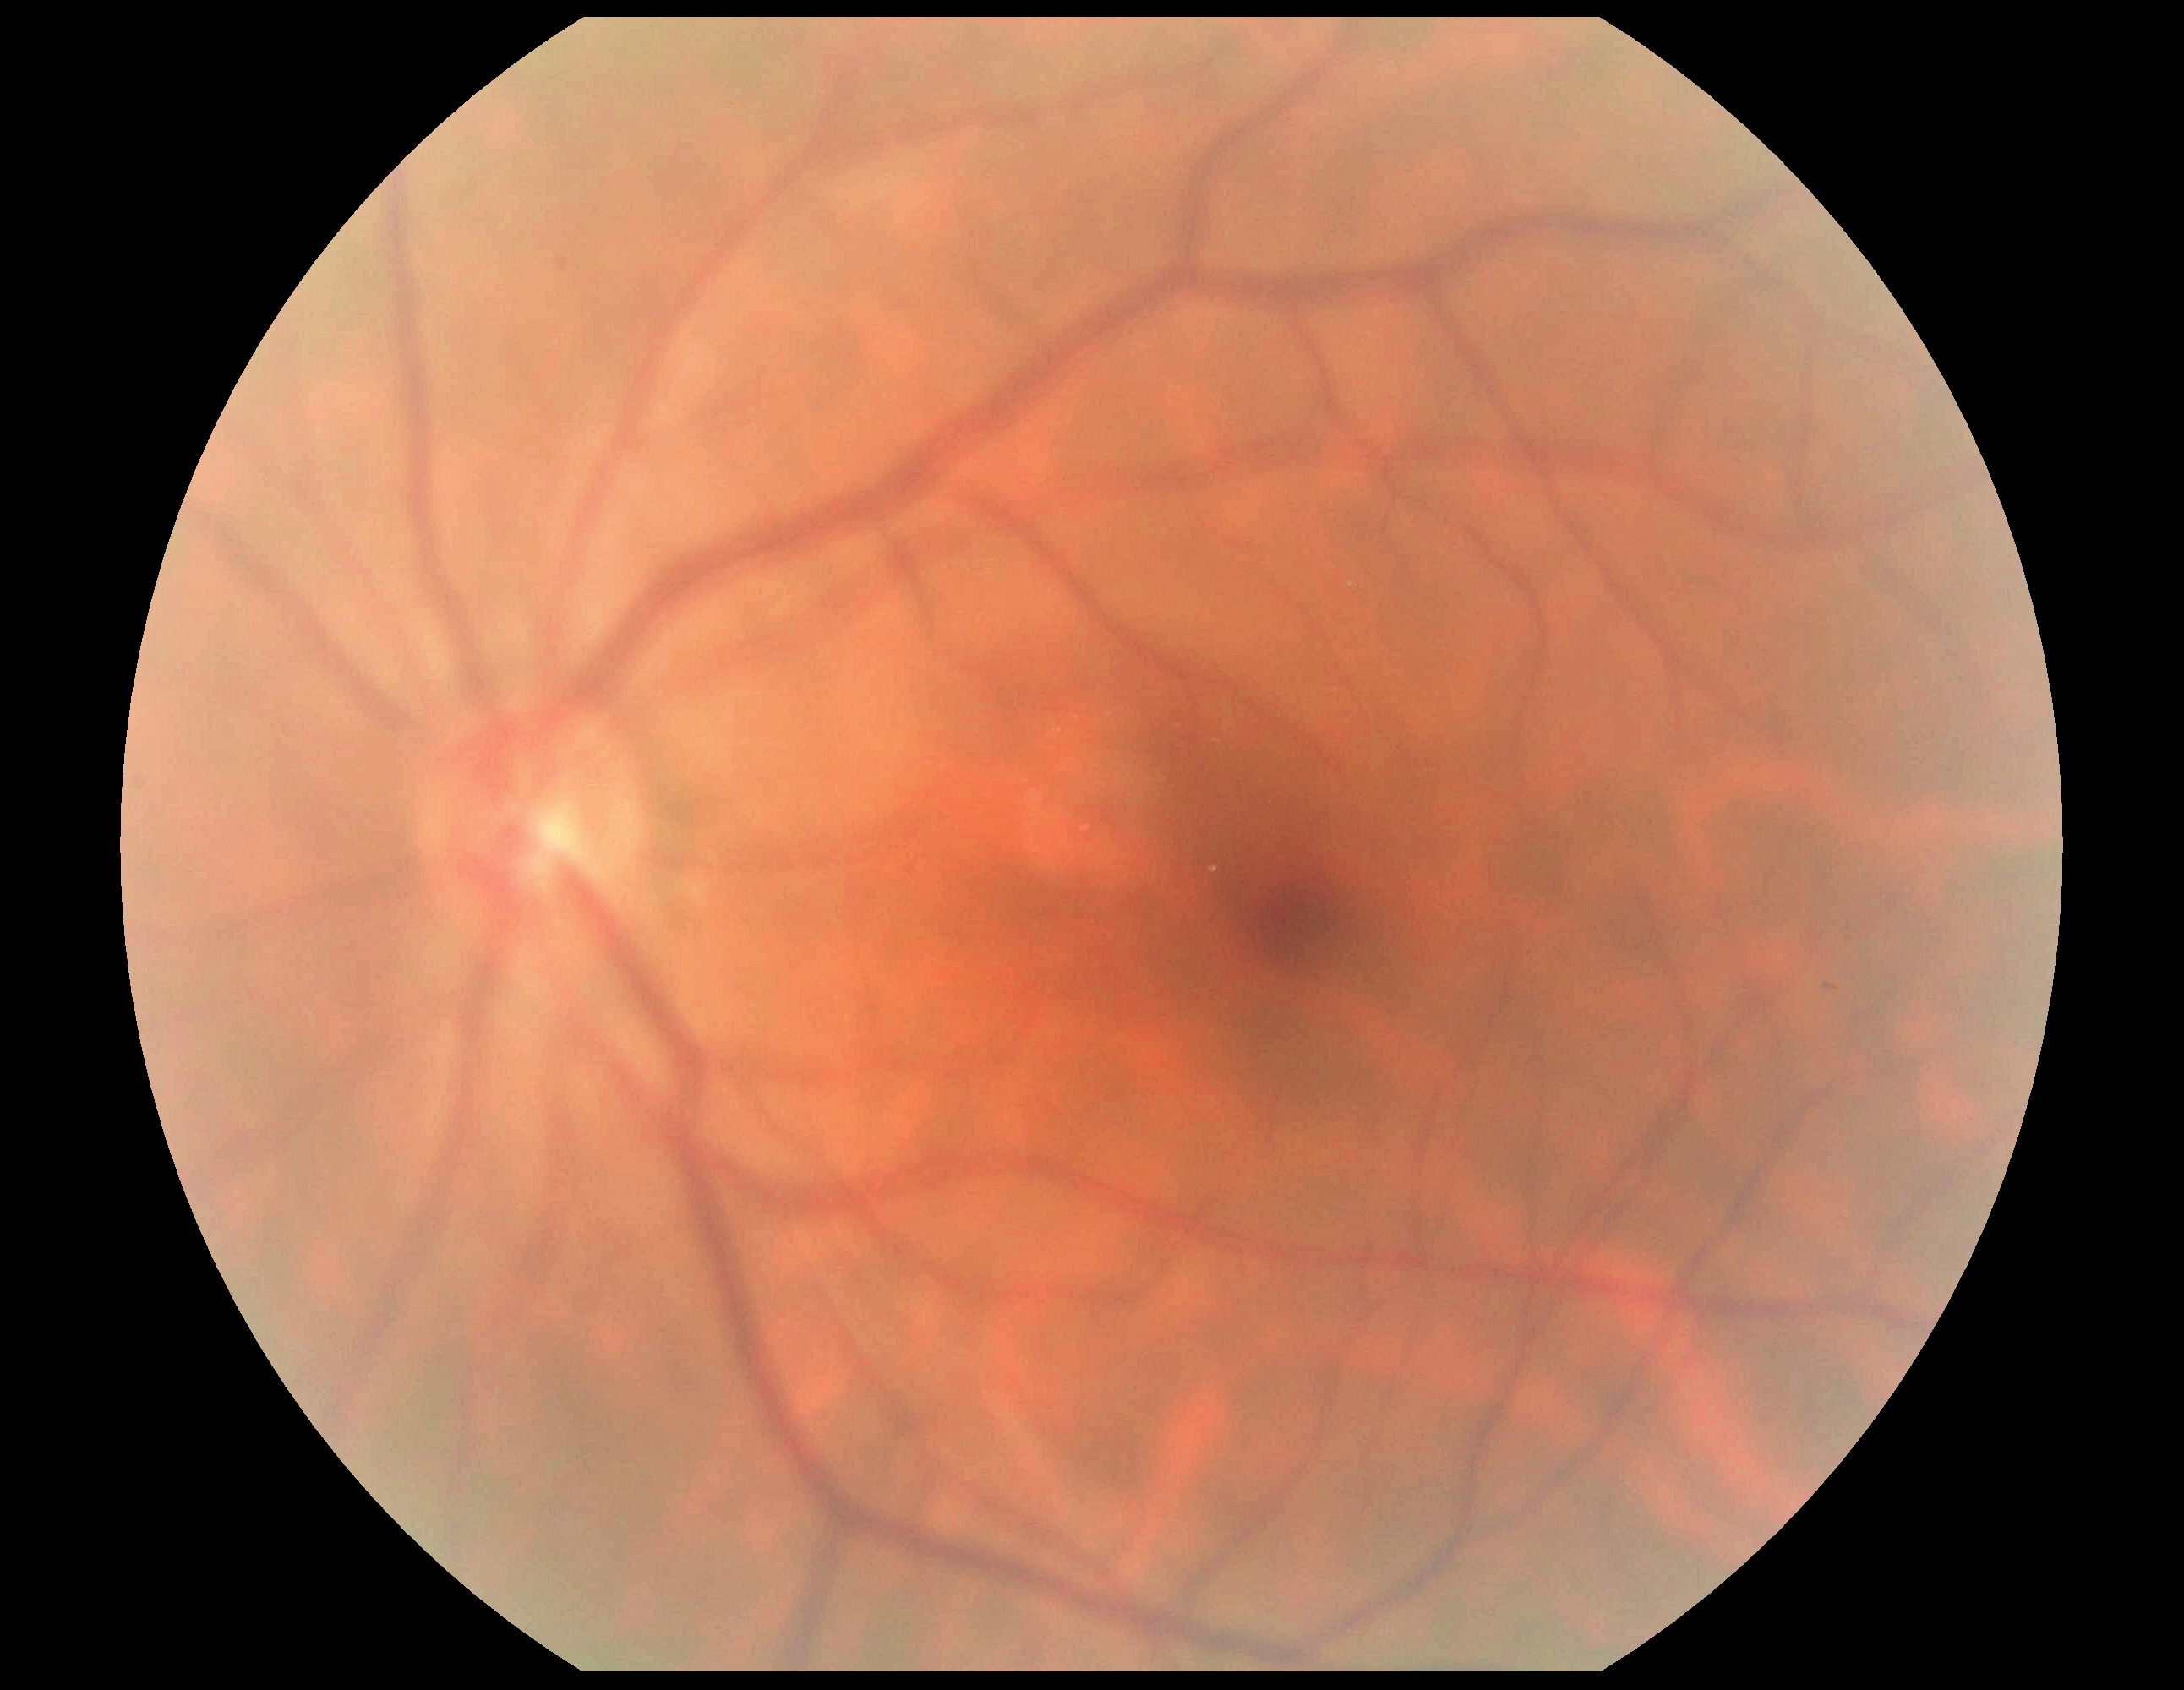
  dr_grade: grade 0 (no apparent retinopathy) — no visible signs of diabetic retinopathy